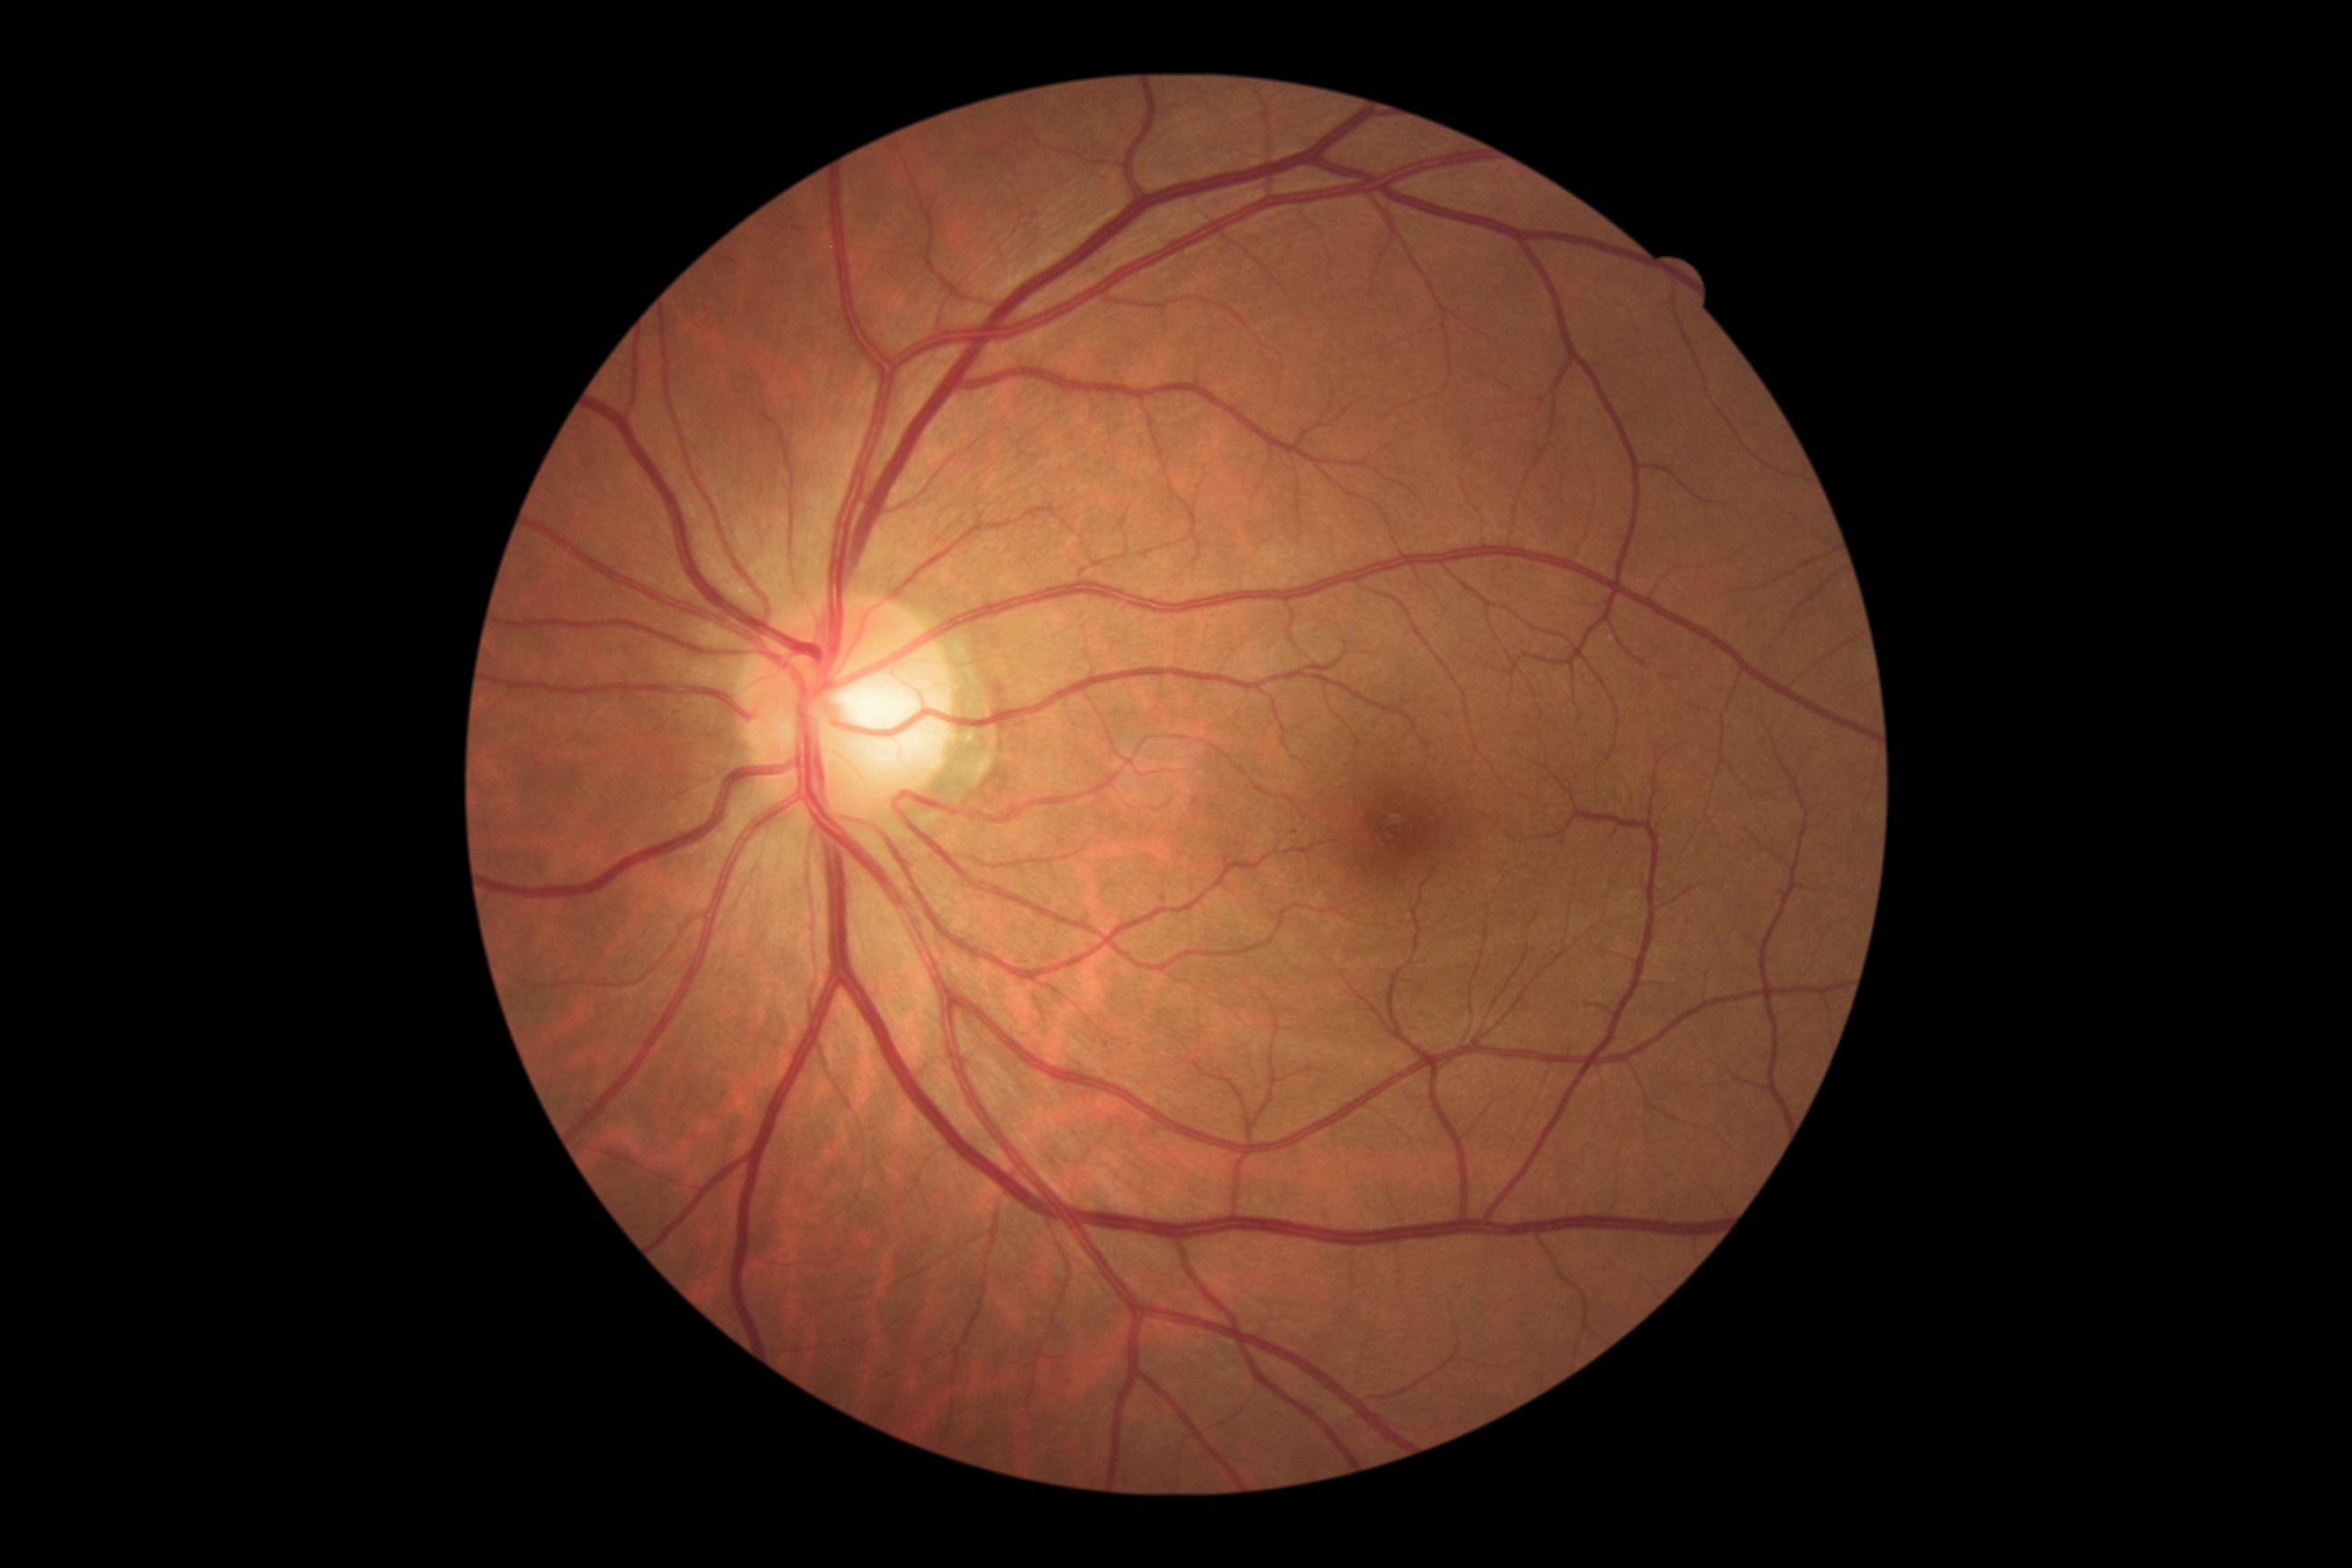 Diabetic retinopathy grade: 1 — presence of microaneurysms only. The retinopathy is classified as non-proliferative diabetic retinopathy.